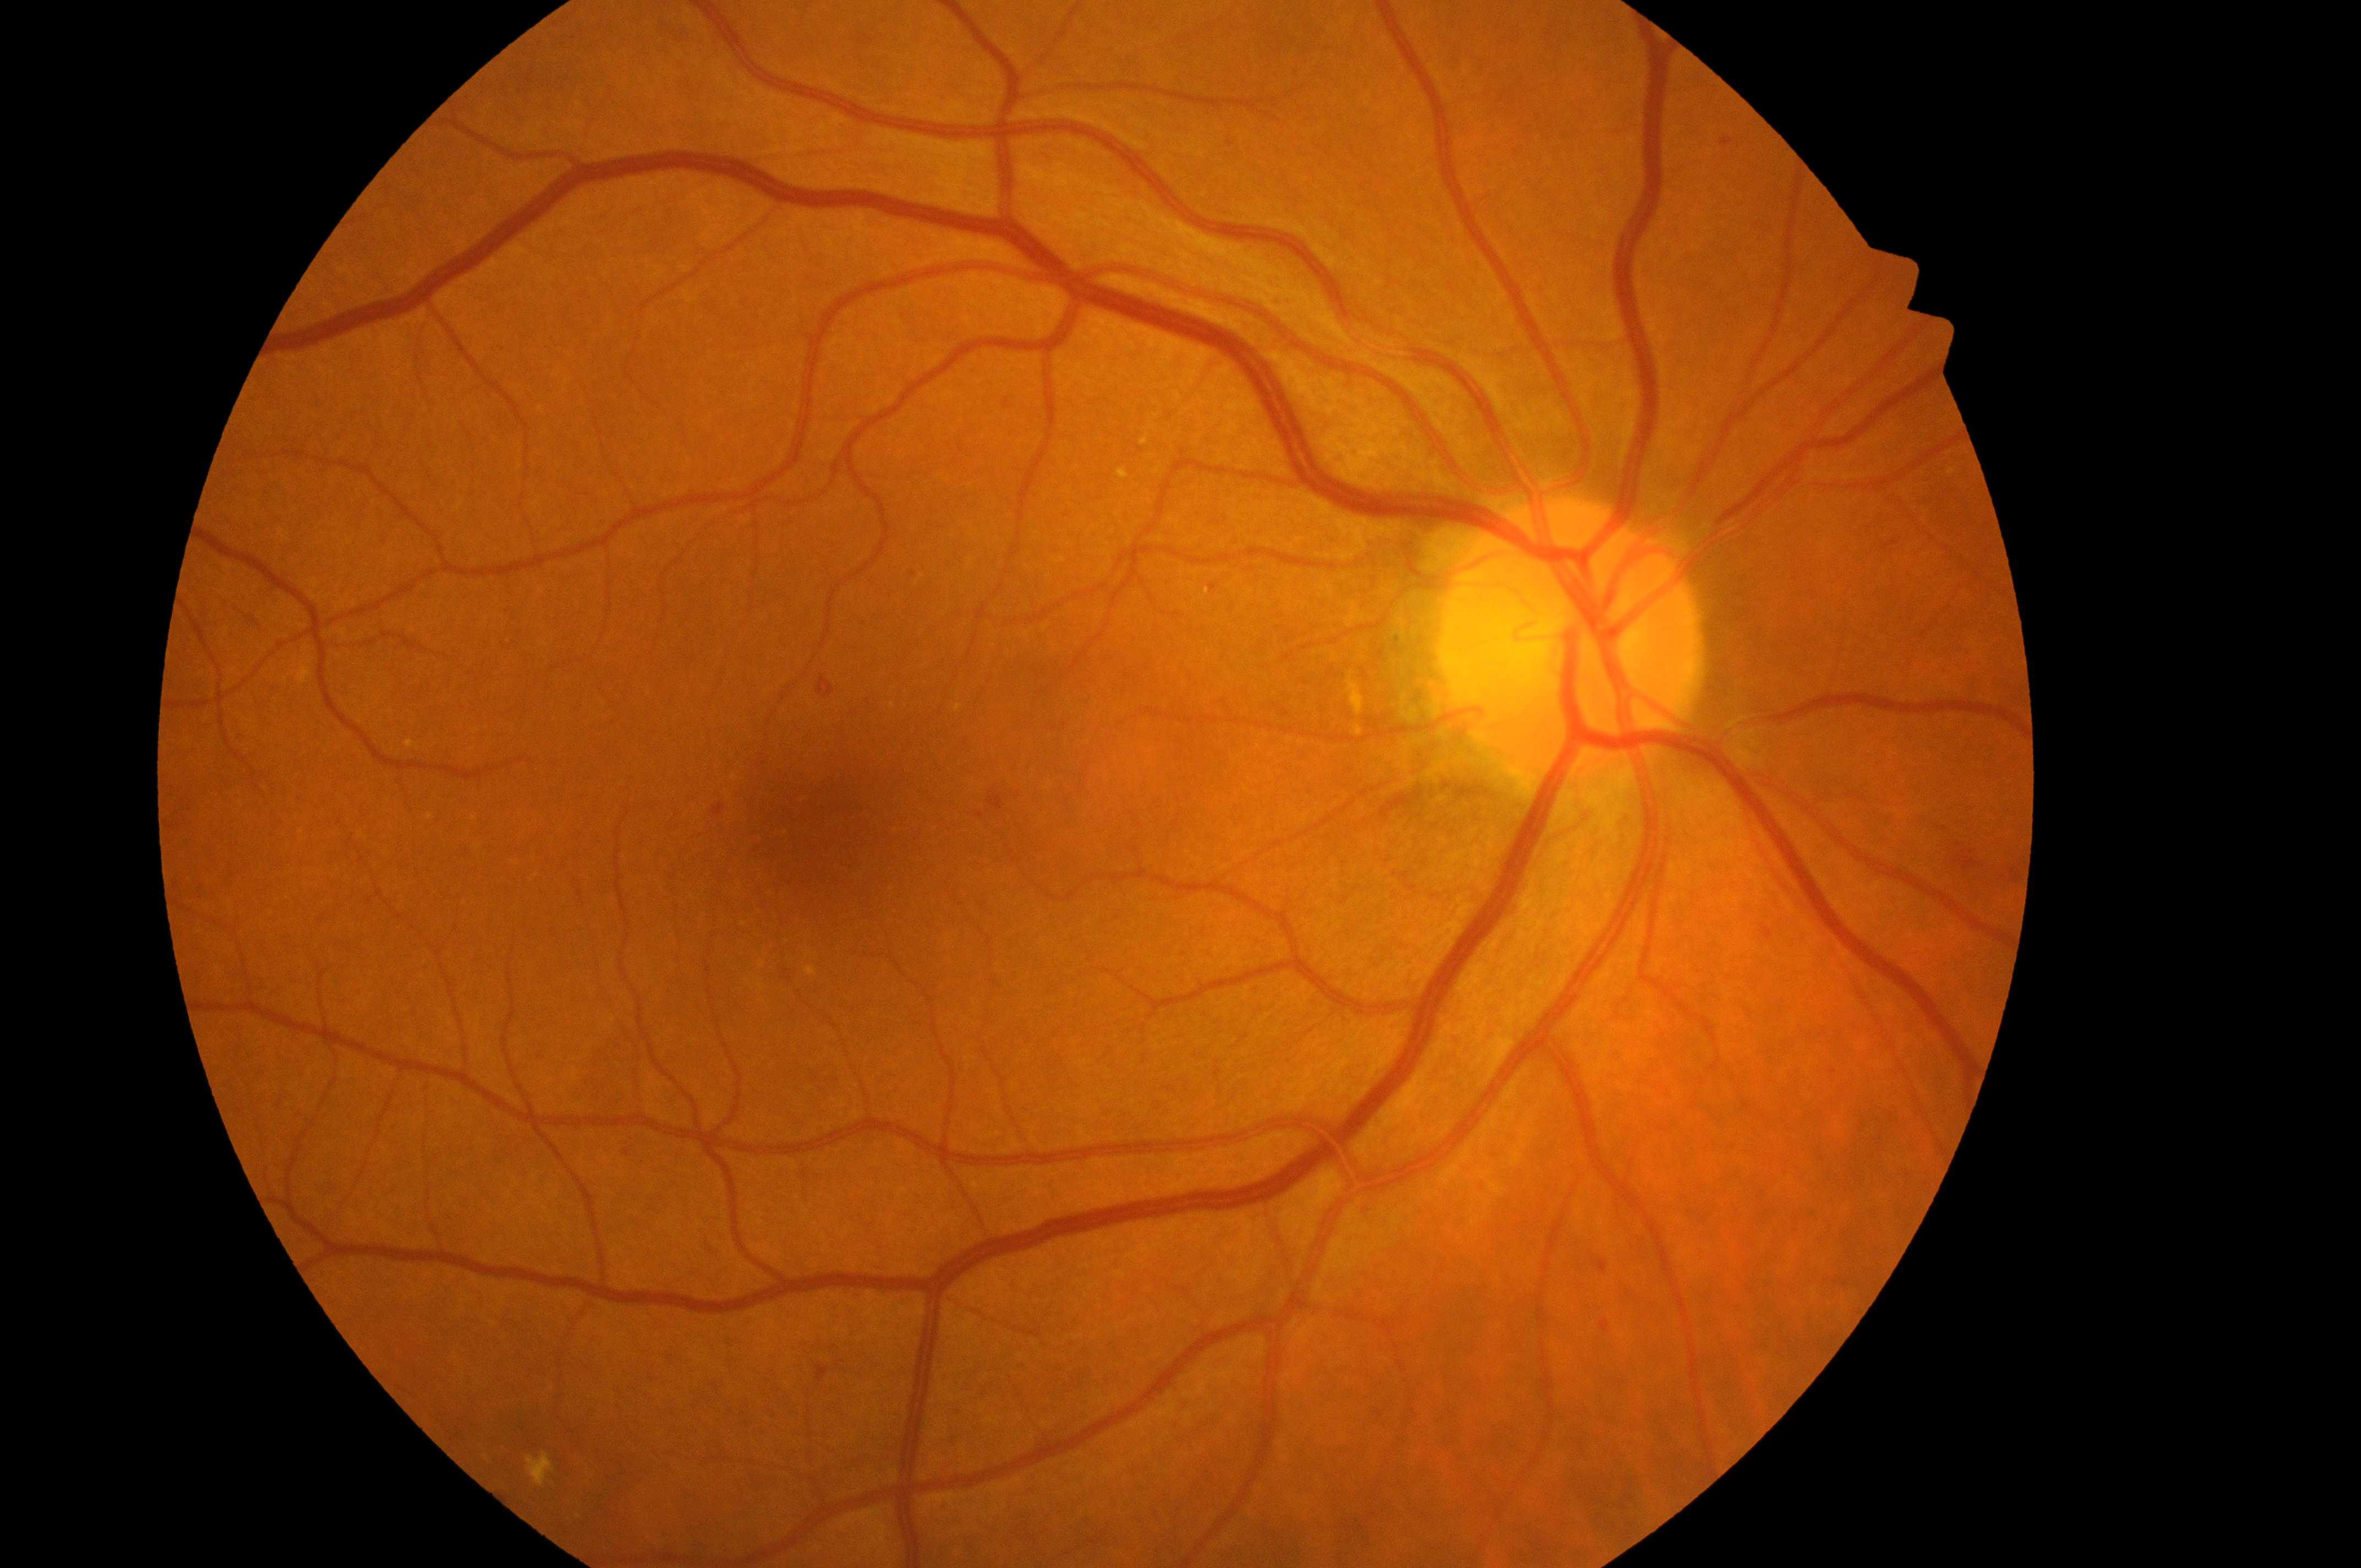

The image shows the right eye. Disease class: non-proliferative diabetic retinopathy. ONH: (1564,651). Diabetic retinopathy (DR) is moderate NPDR (grade 2). Diabetic macular edema (DME) is grade 2 (high risk). Fovea located at (829,831).